Phoenix ICON wide-field infant fundus image; Phoenix ICON, 100° FOV — 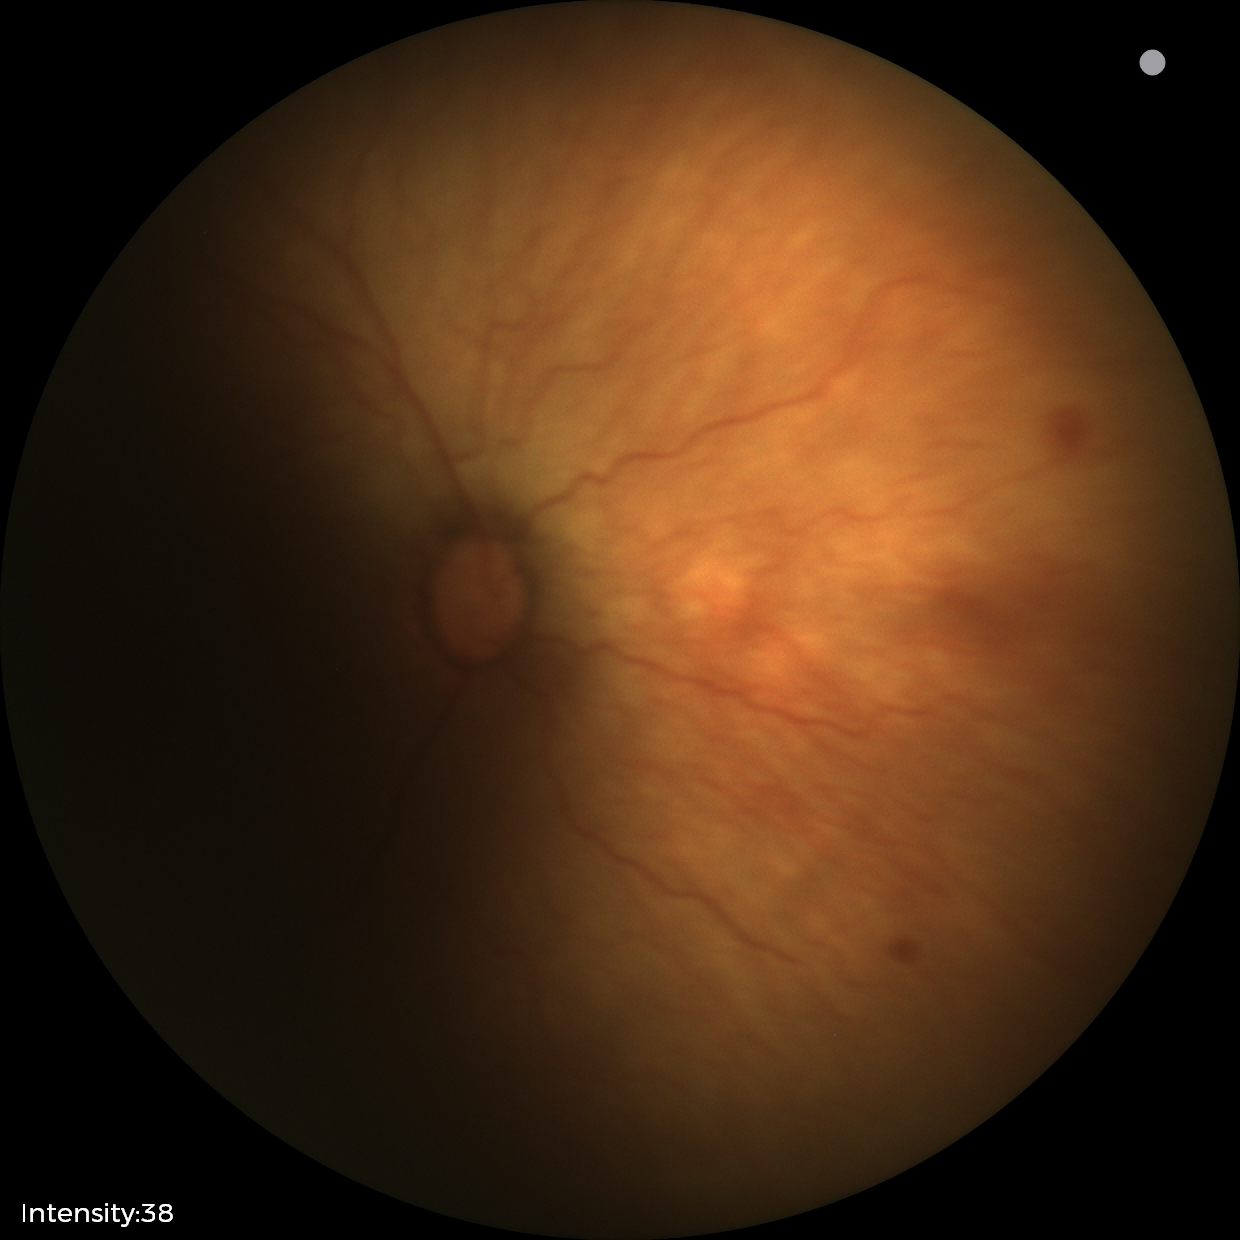
Screening series with retinopathy of prematurity stage 1.